Acquired with a NIDEK AFC-230
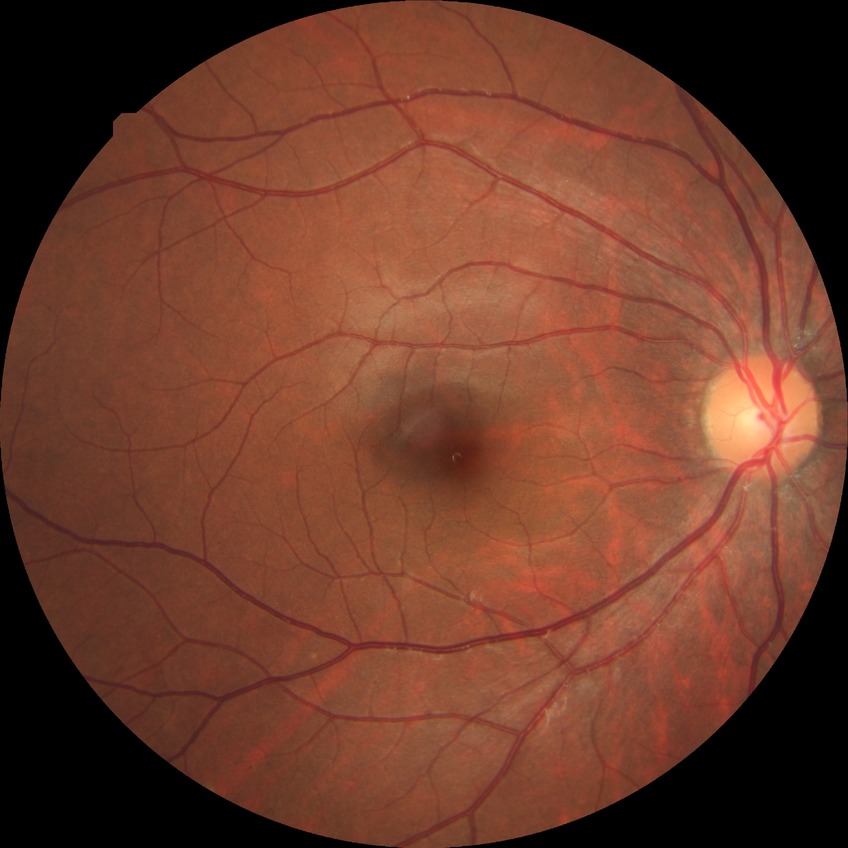

diabetic retinopathy (DR) = NDR (no diabetic retinopathy).